Image size 1240x1240; camera: Phoenix ICON (100° FOV); pediatric retinal photograph (wide-field)
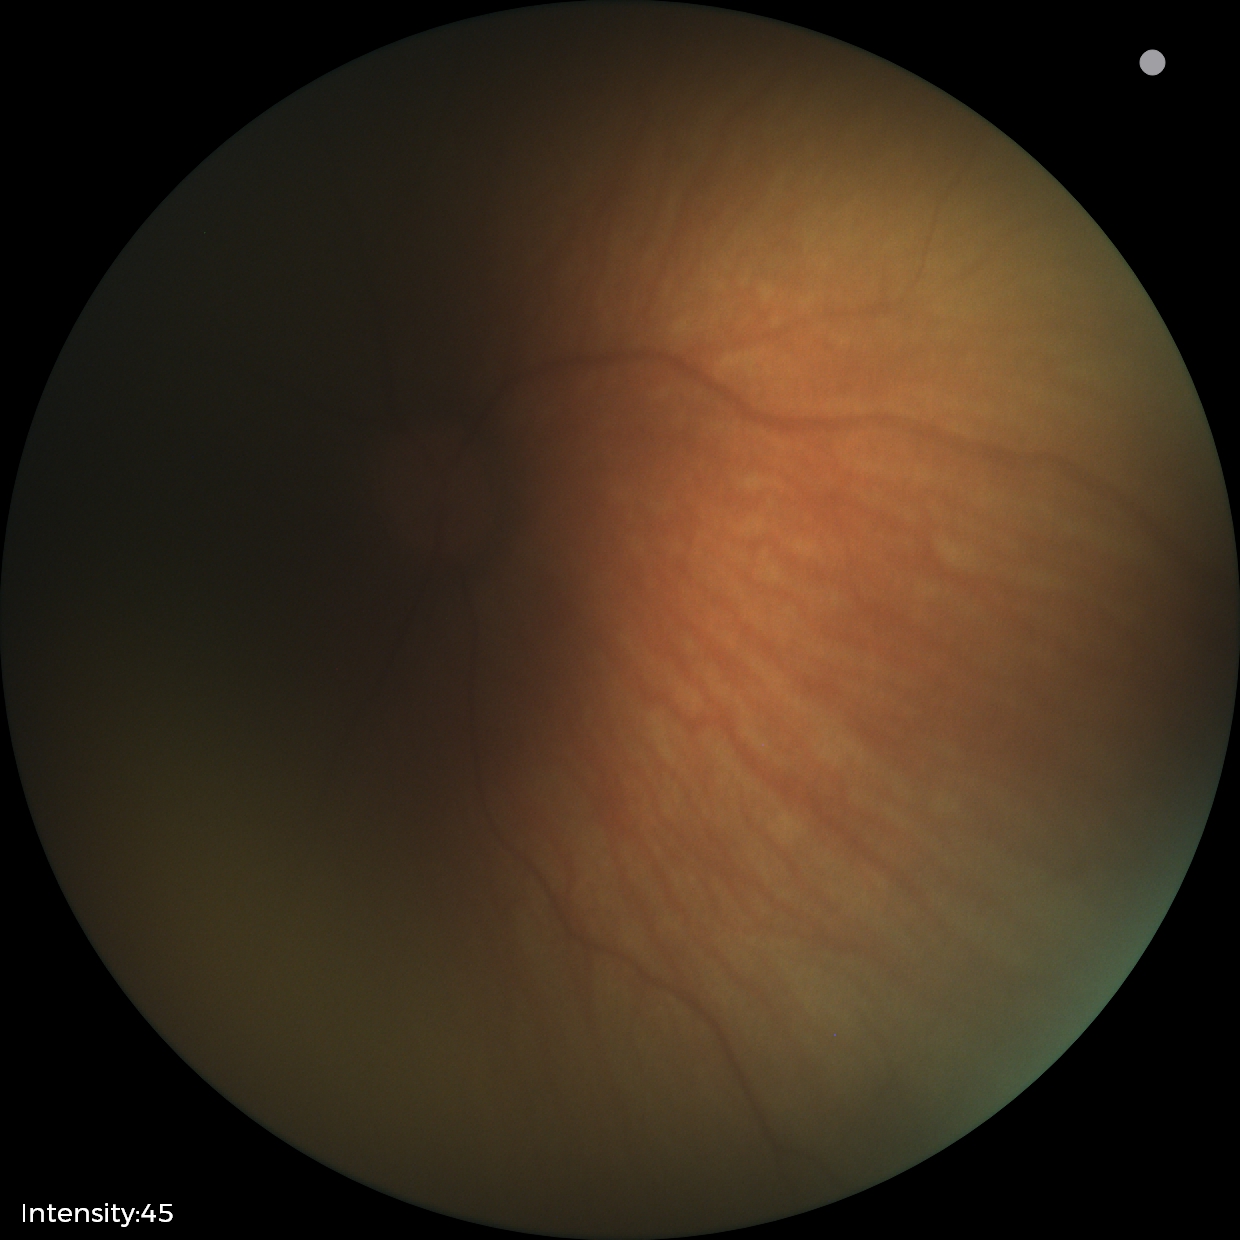

Normal screening examination.